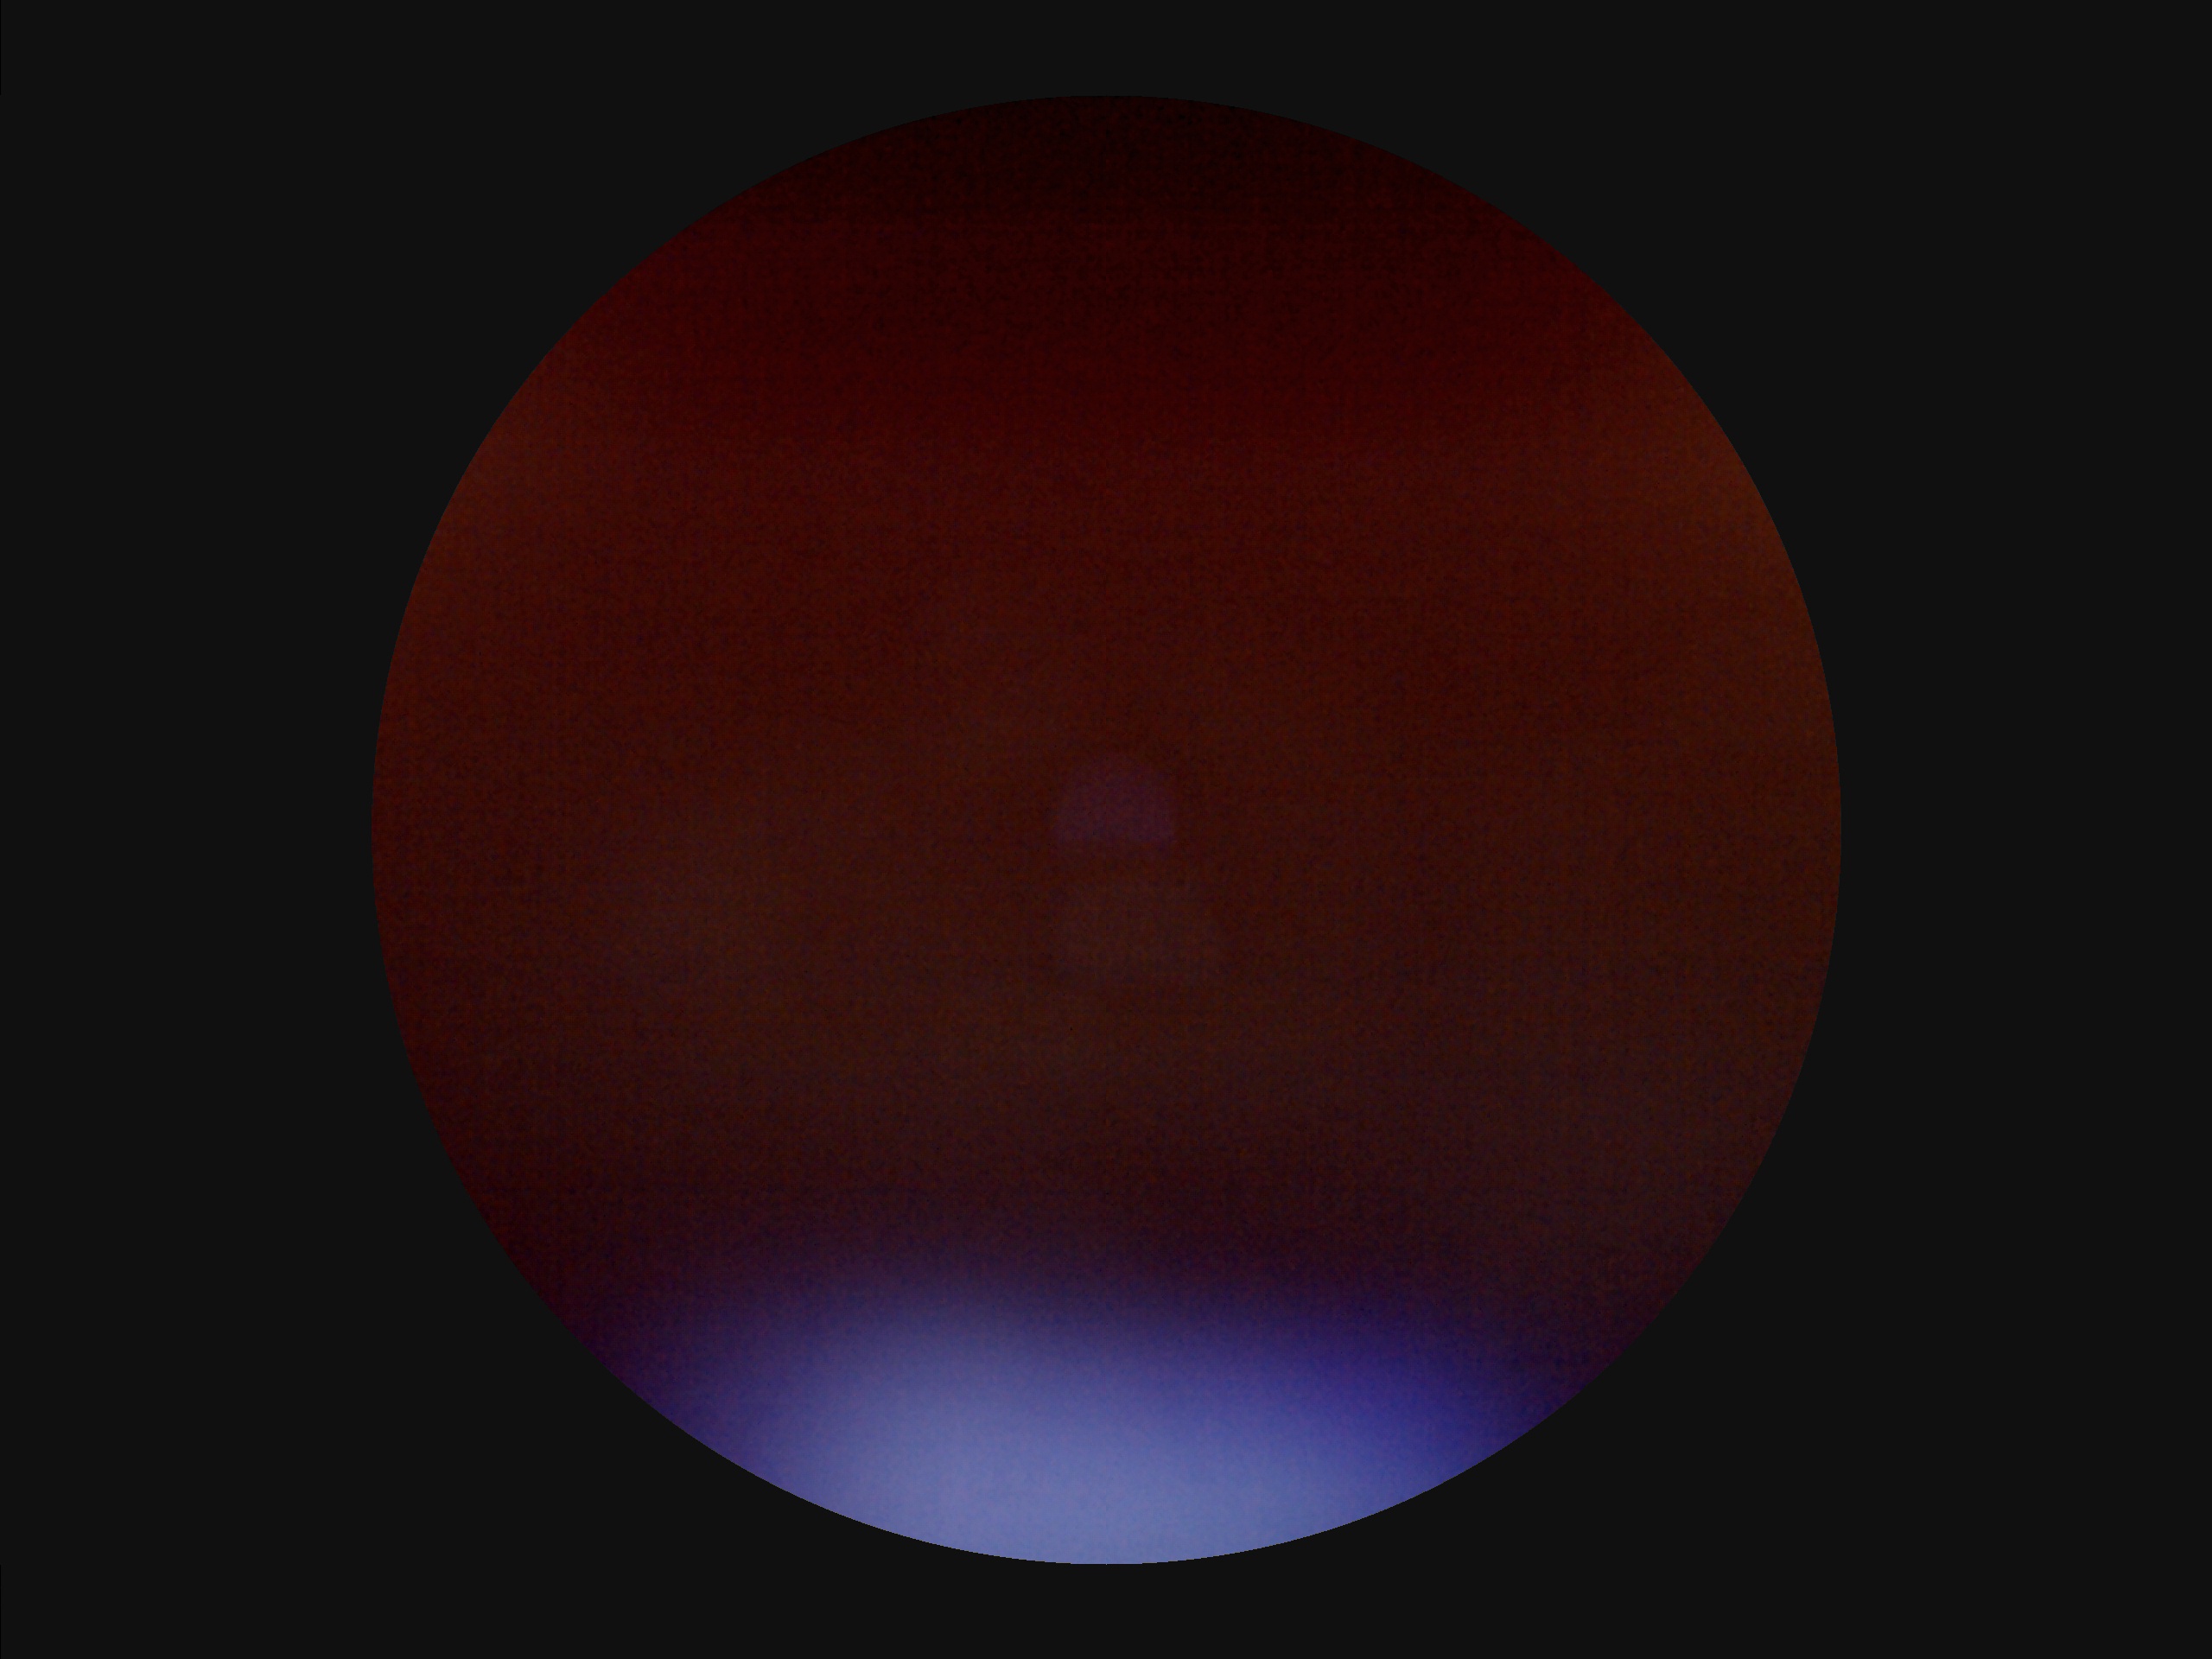 Out of focus; structures are indistinct.
There is over- or under-exposure or a color cast.
Poor dynamic range.
Image quality is suboptimal.